Wide-field fundus photograph from neonatal ROP screening. Image size 640x480 — 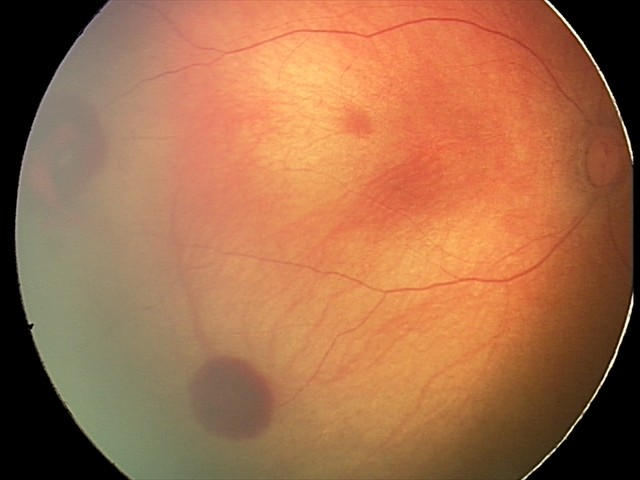
Diagnosis from this screening exam: retinal hemorrhages.